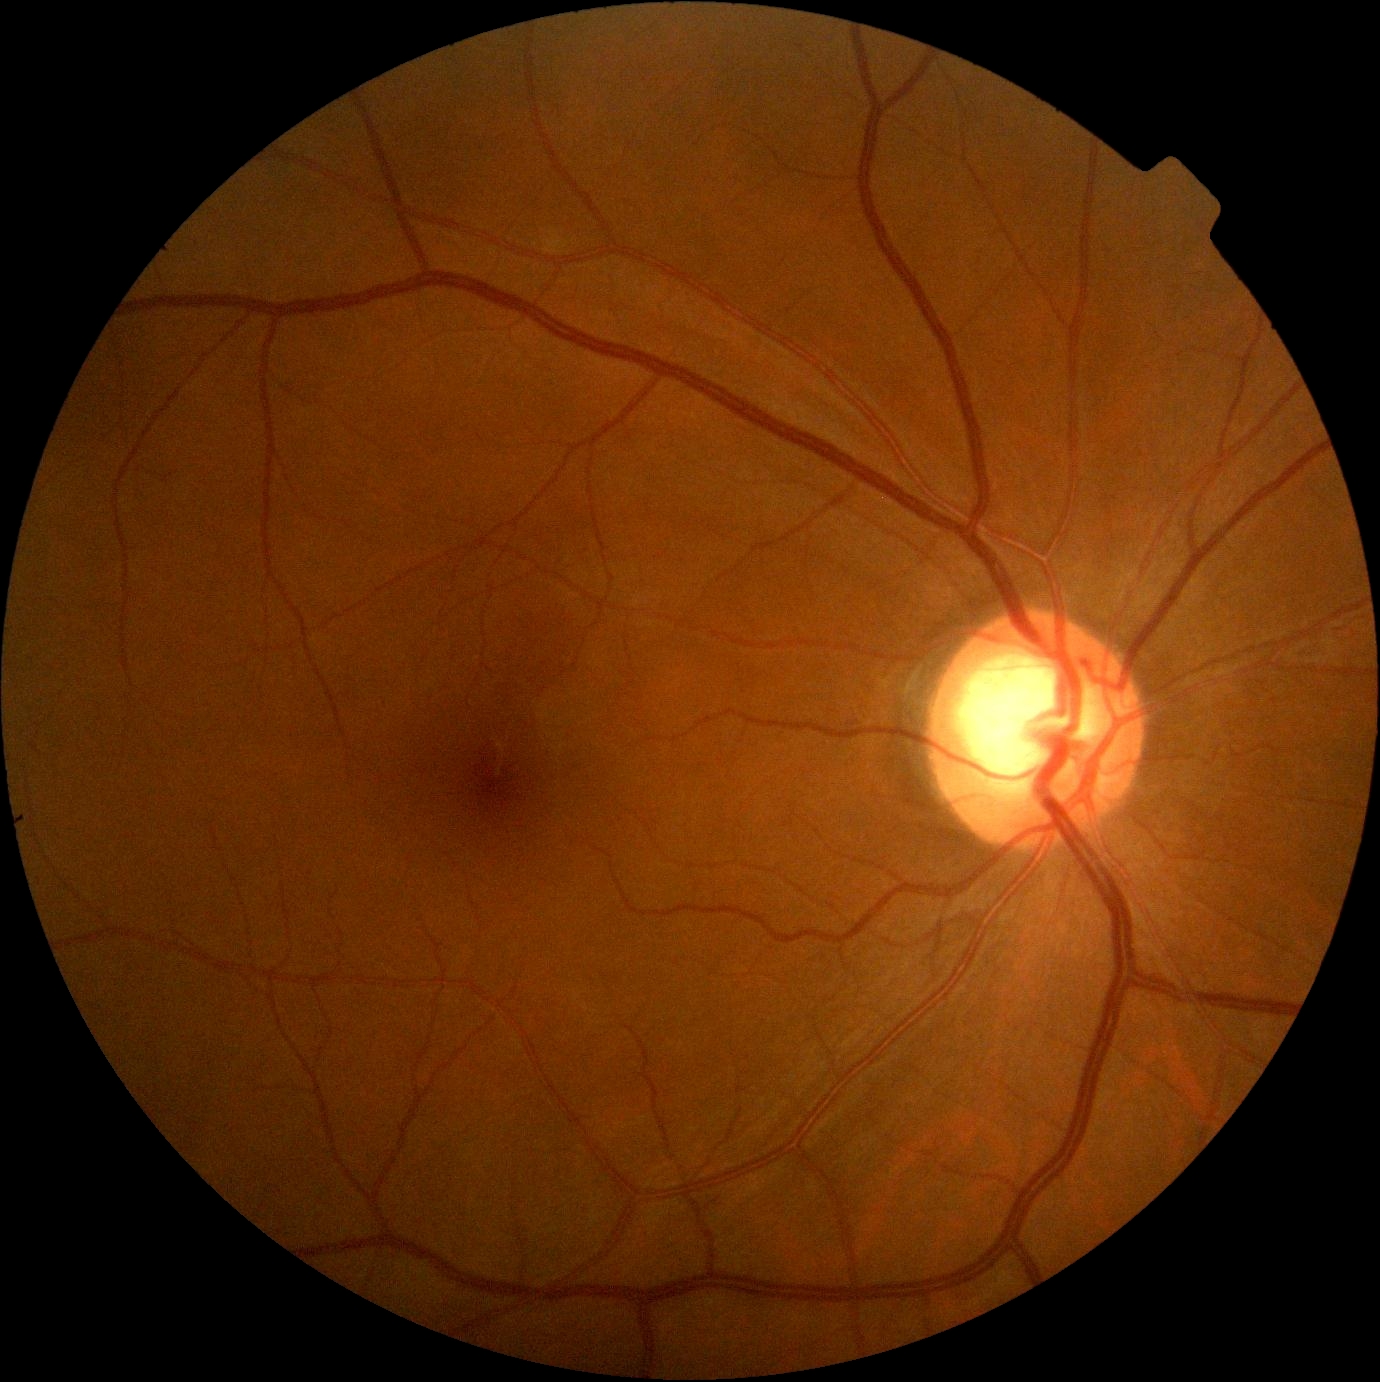
Findings:
* DR — grade 0 (no apparent retinopathy)